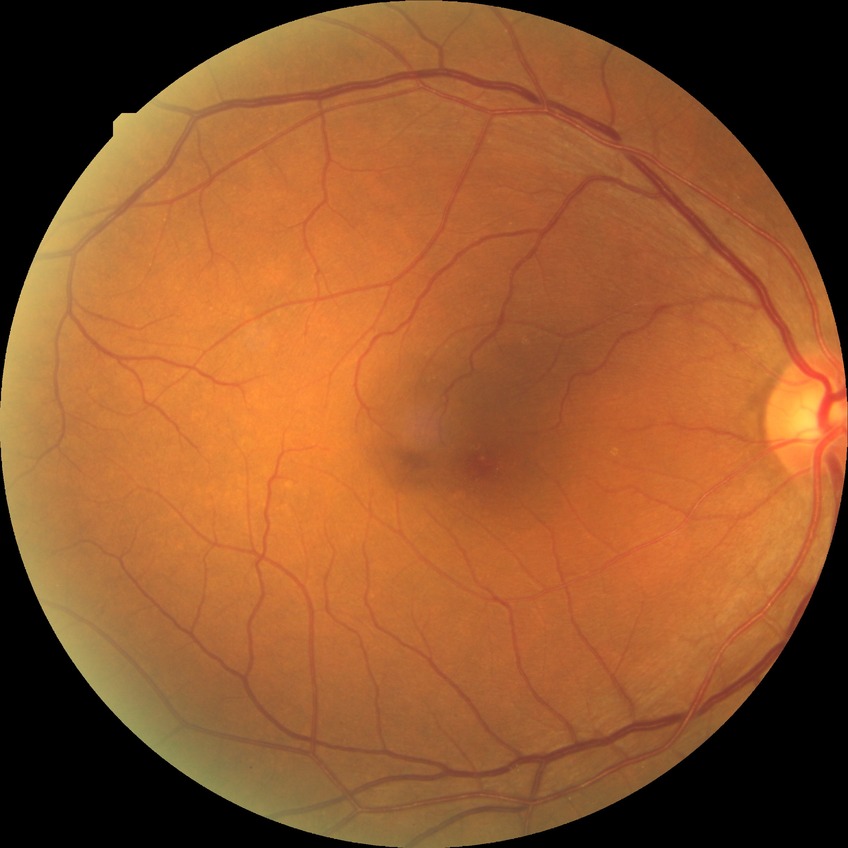
Diabetic retinopathy (DR): NDR (no diabetic retinopathy).